Posterior pole color fundus photograph, acquired with a NIDEK AFC-230, without pupil dilation, 848 x 848 pixels: 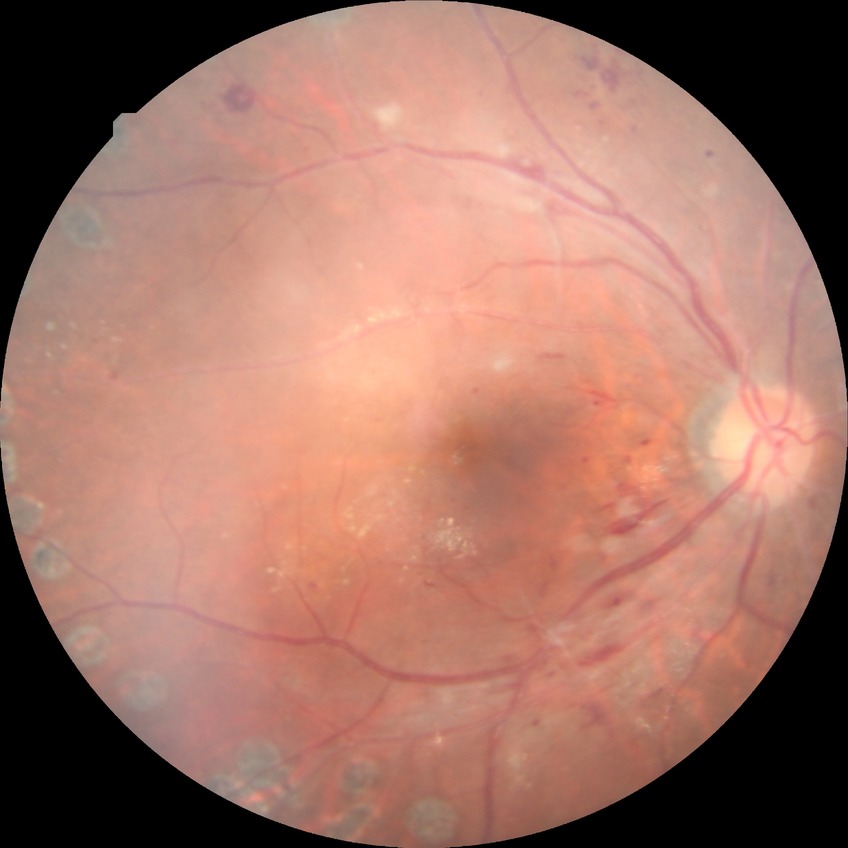
• diabetic retinopathy (DR) — PDR (proliferative diabetic retinopathy)